1240x1240 · wide-field fundus photograph of an infant: 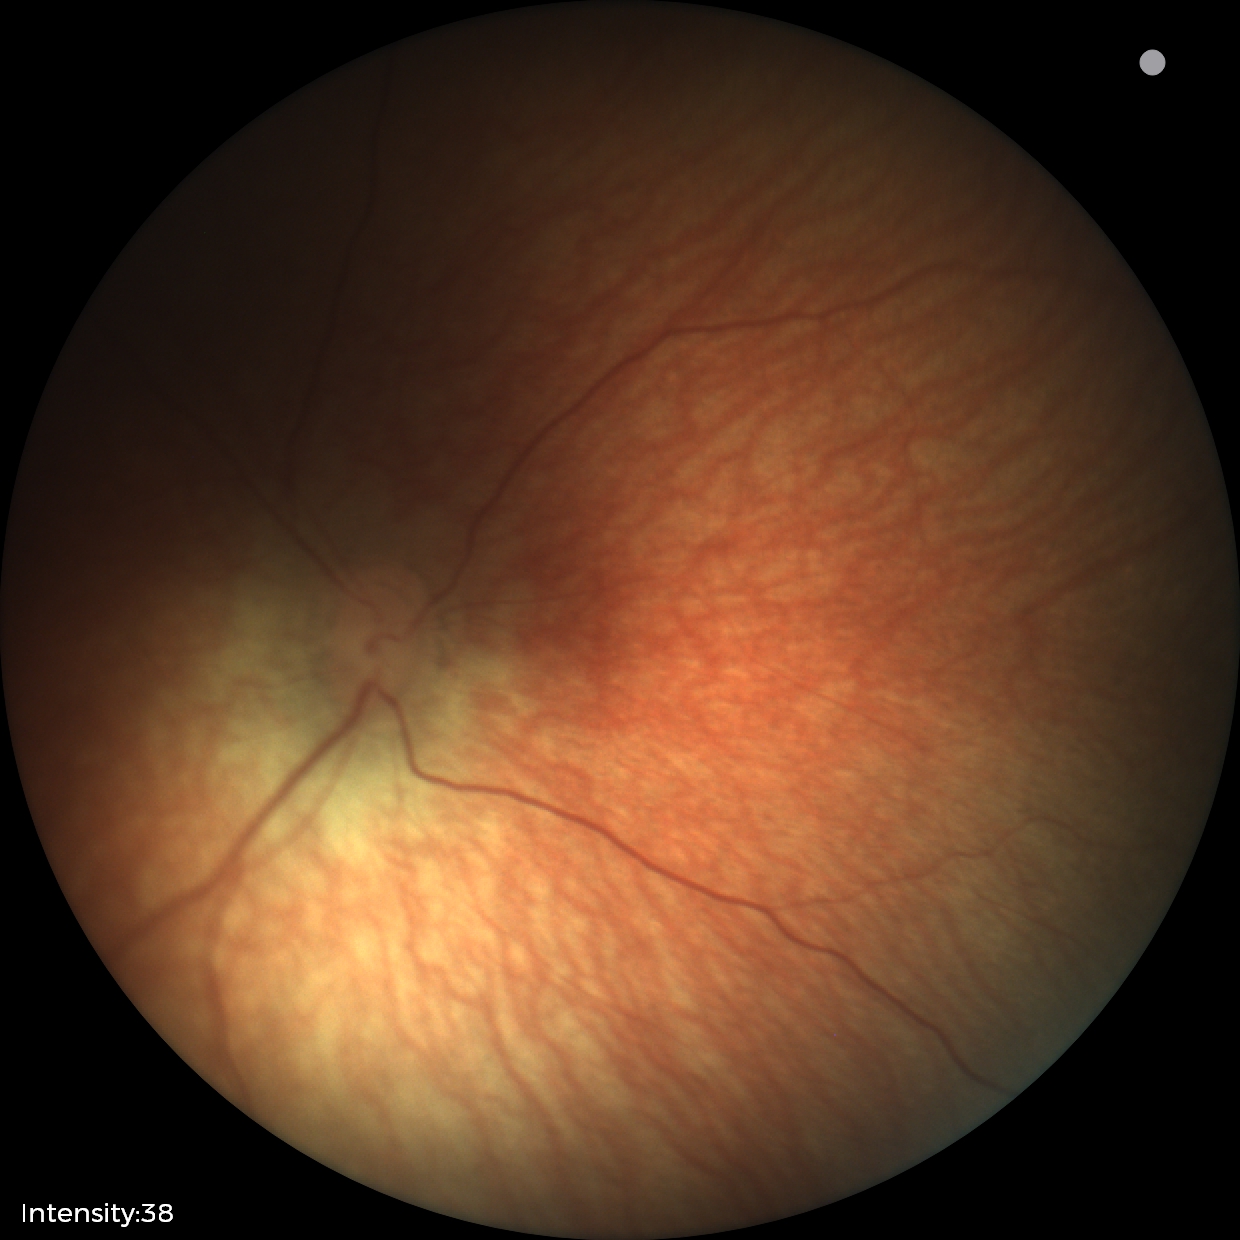 Normal screening examination.